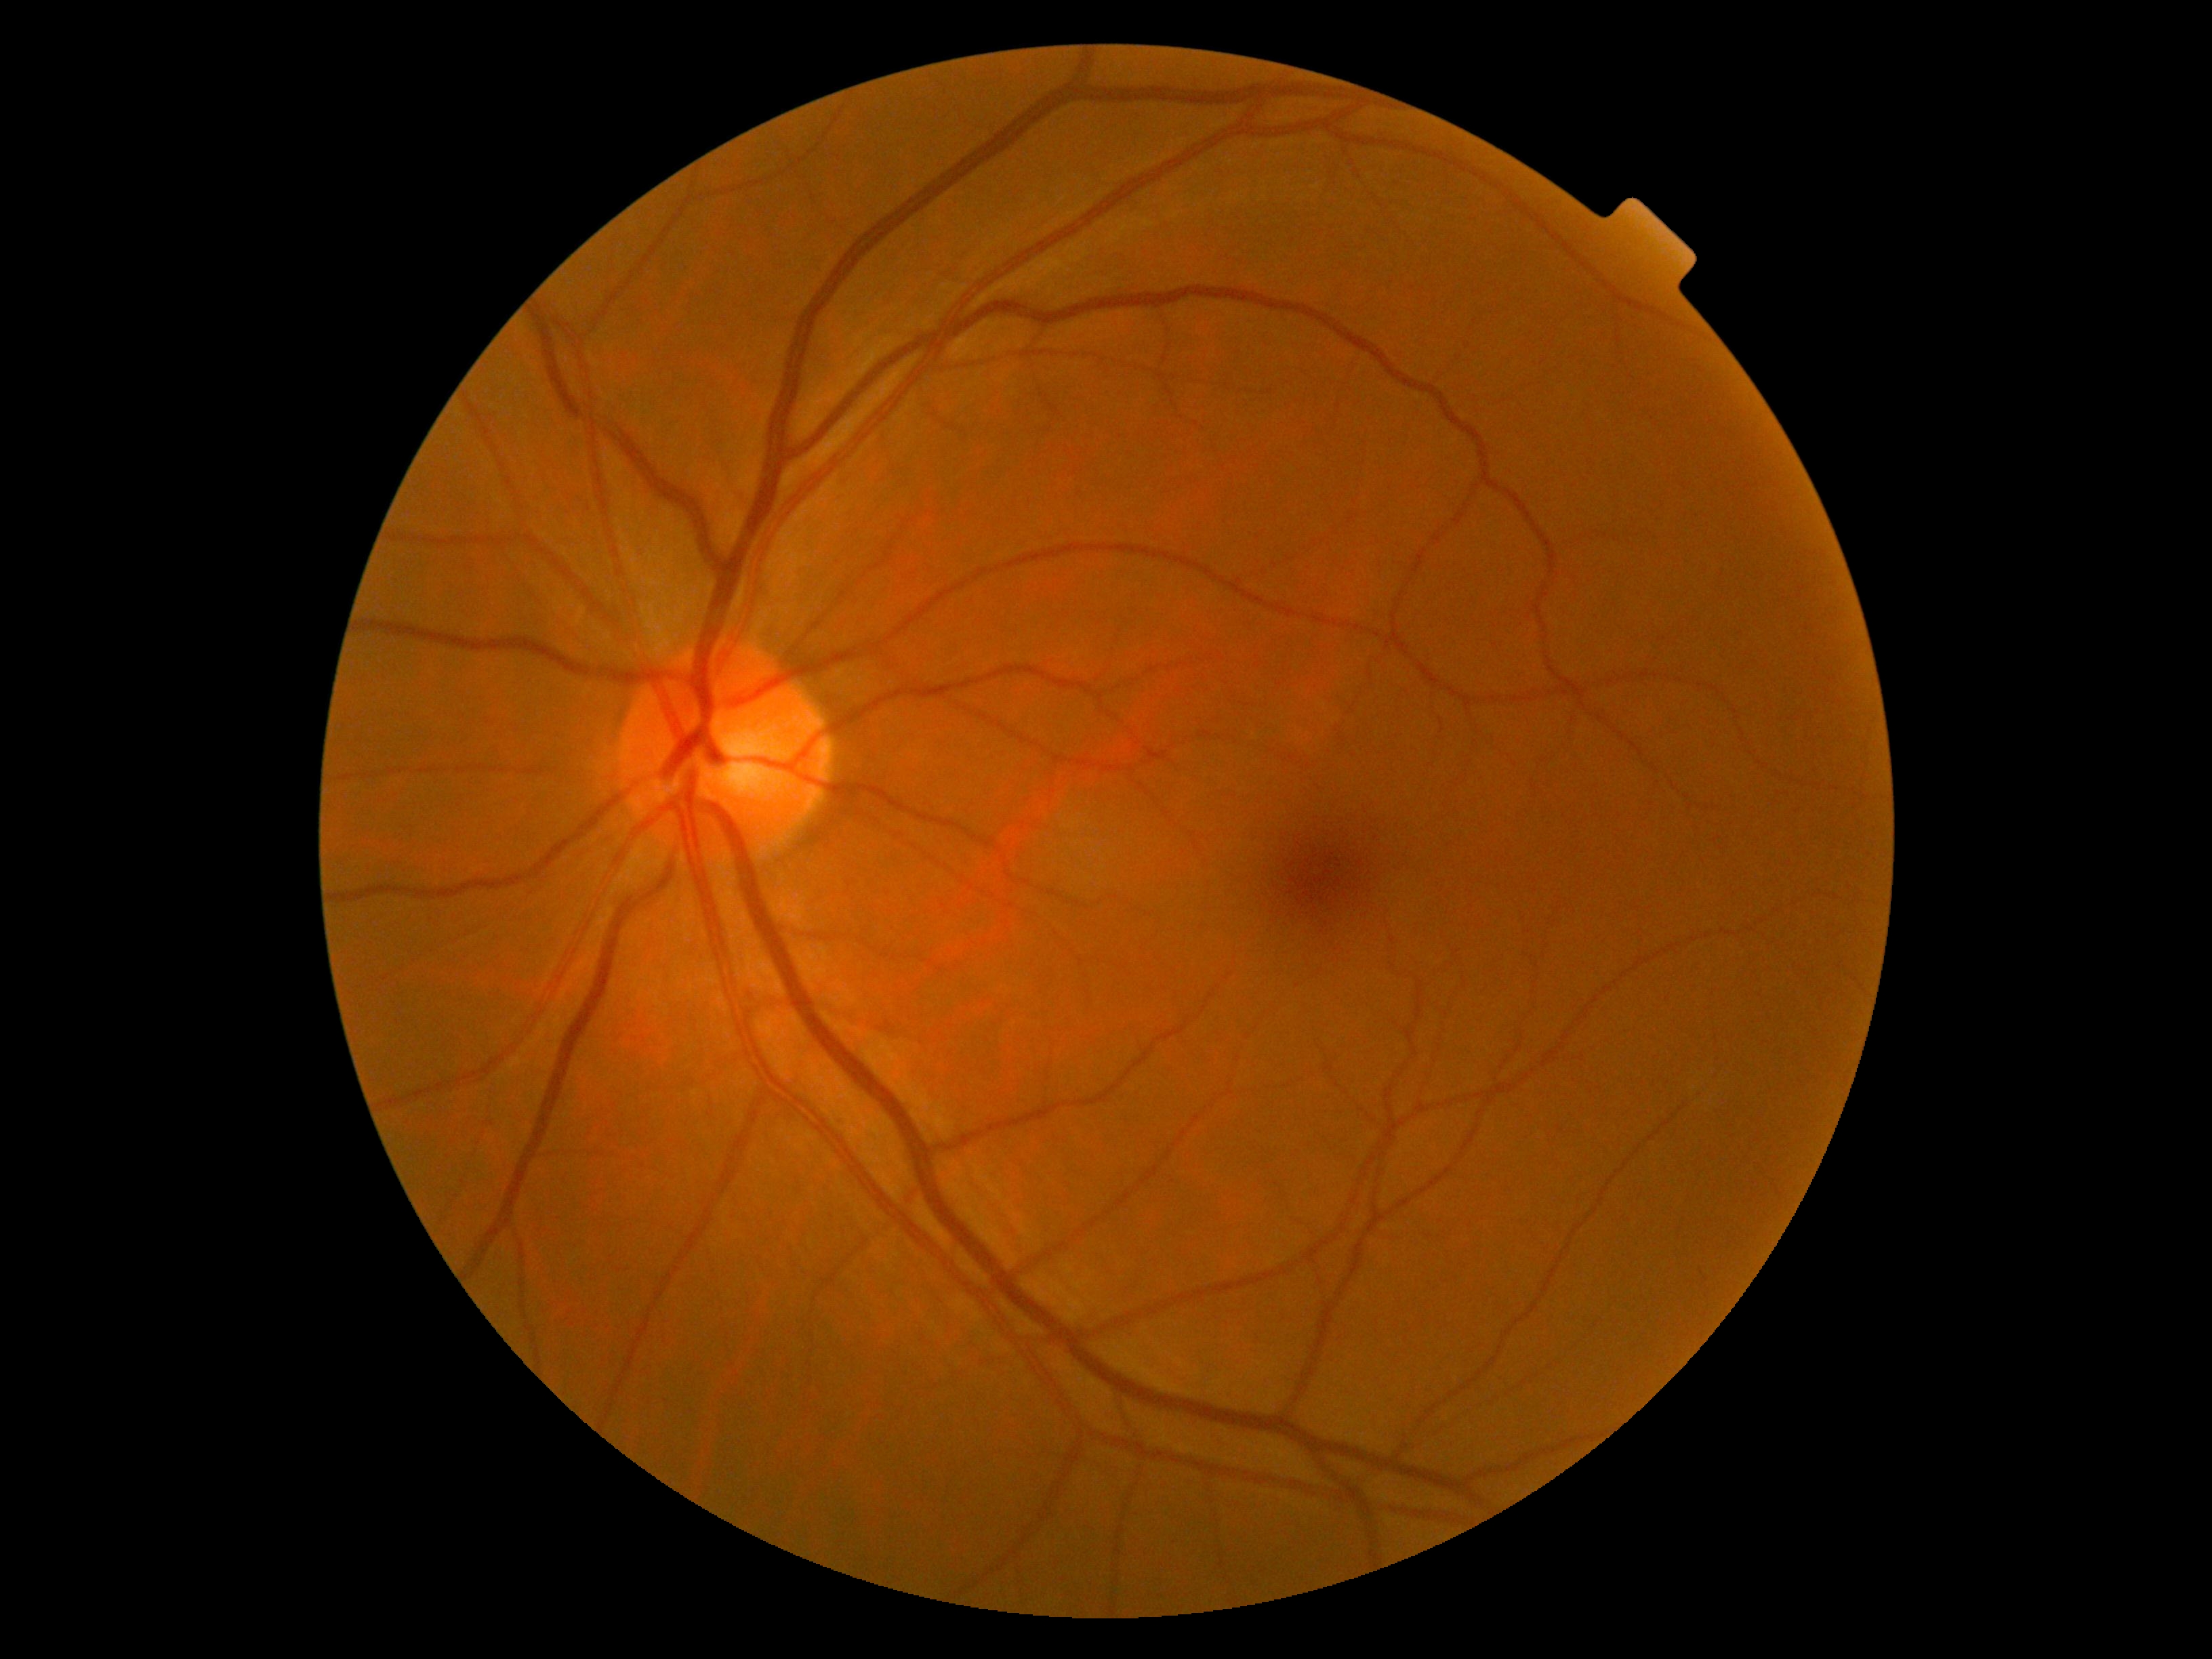
DR grade: 0 — no visible signs of diabetic retinopathy.